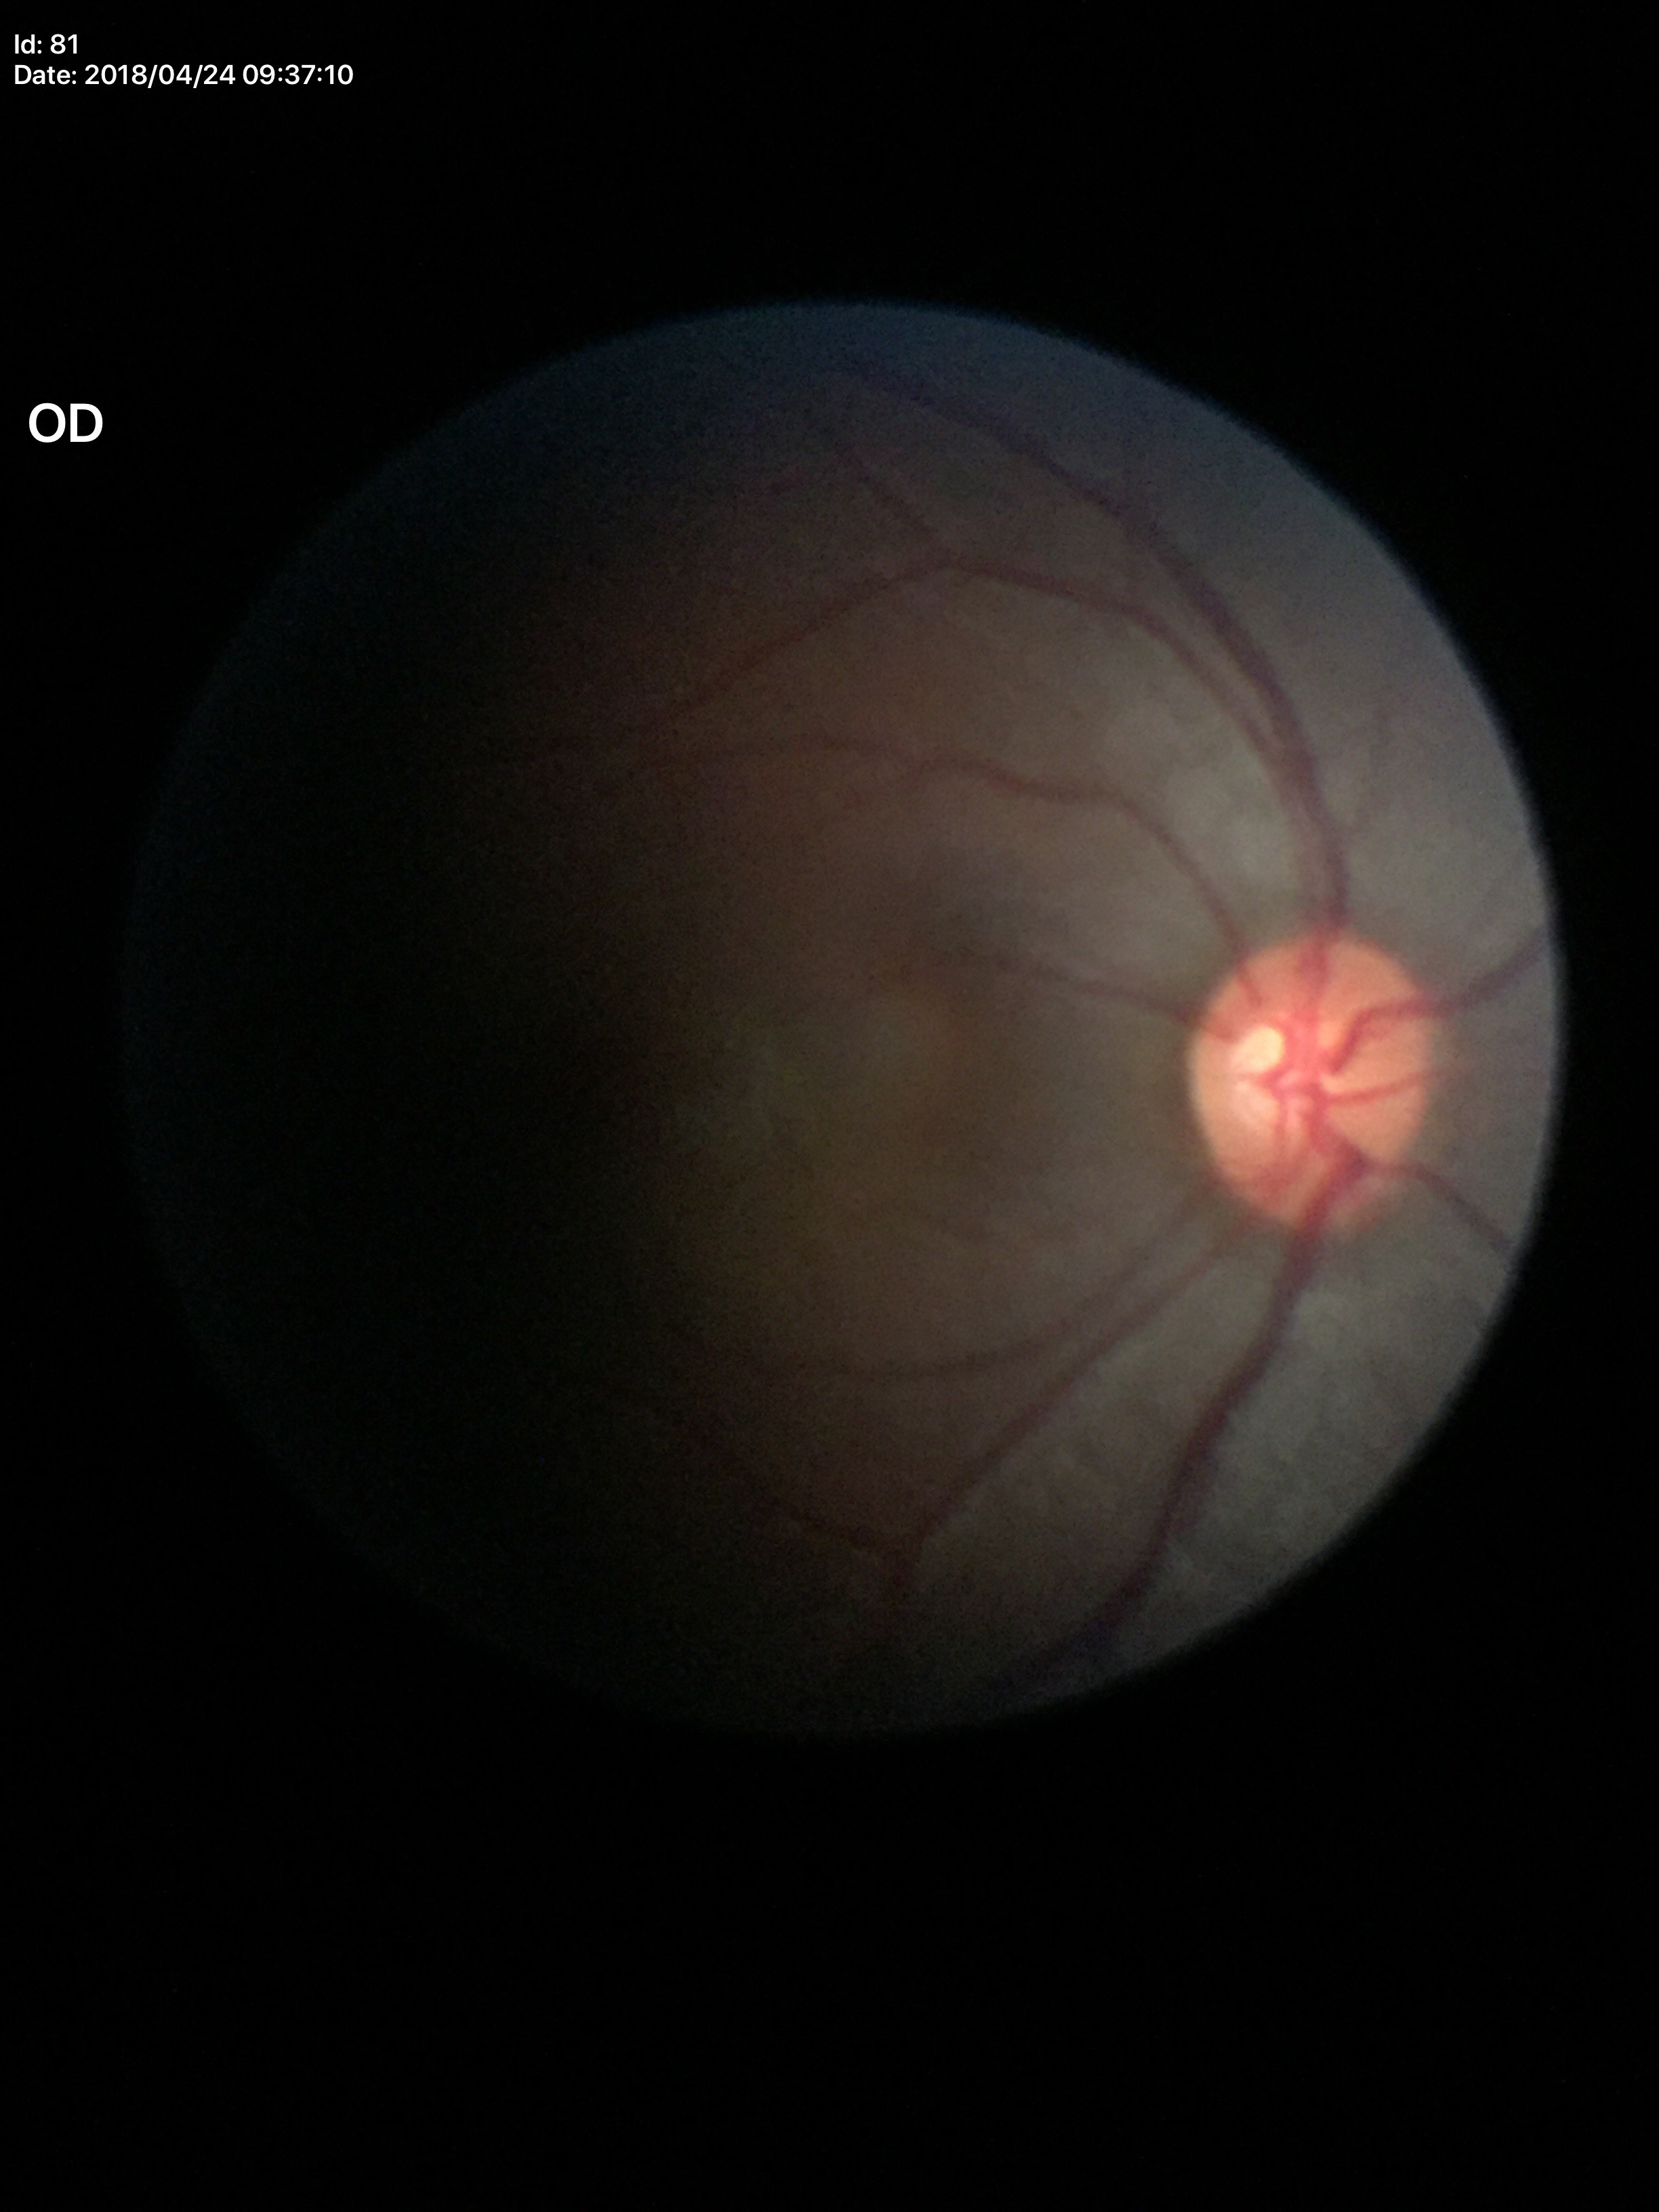 vertical C/D ratio=0.56 | Glaucoma assessment=negative (2/5 graders called glaucoma suspect)